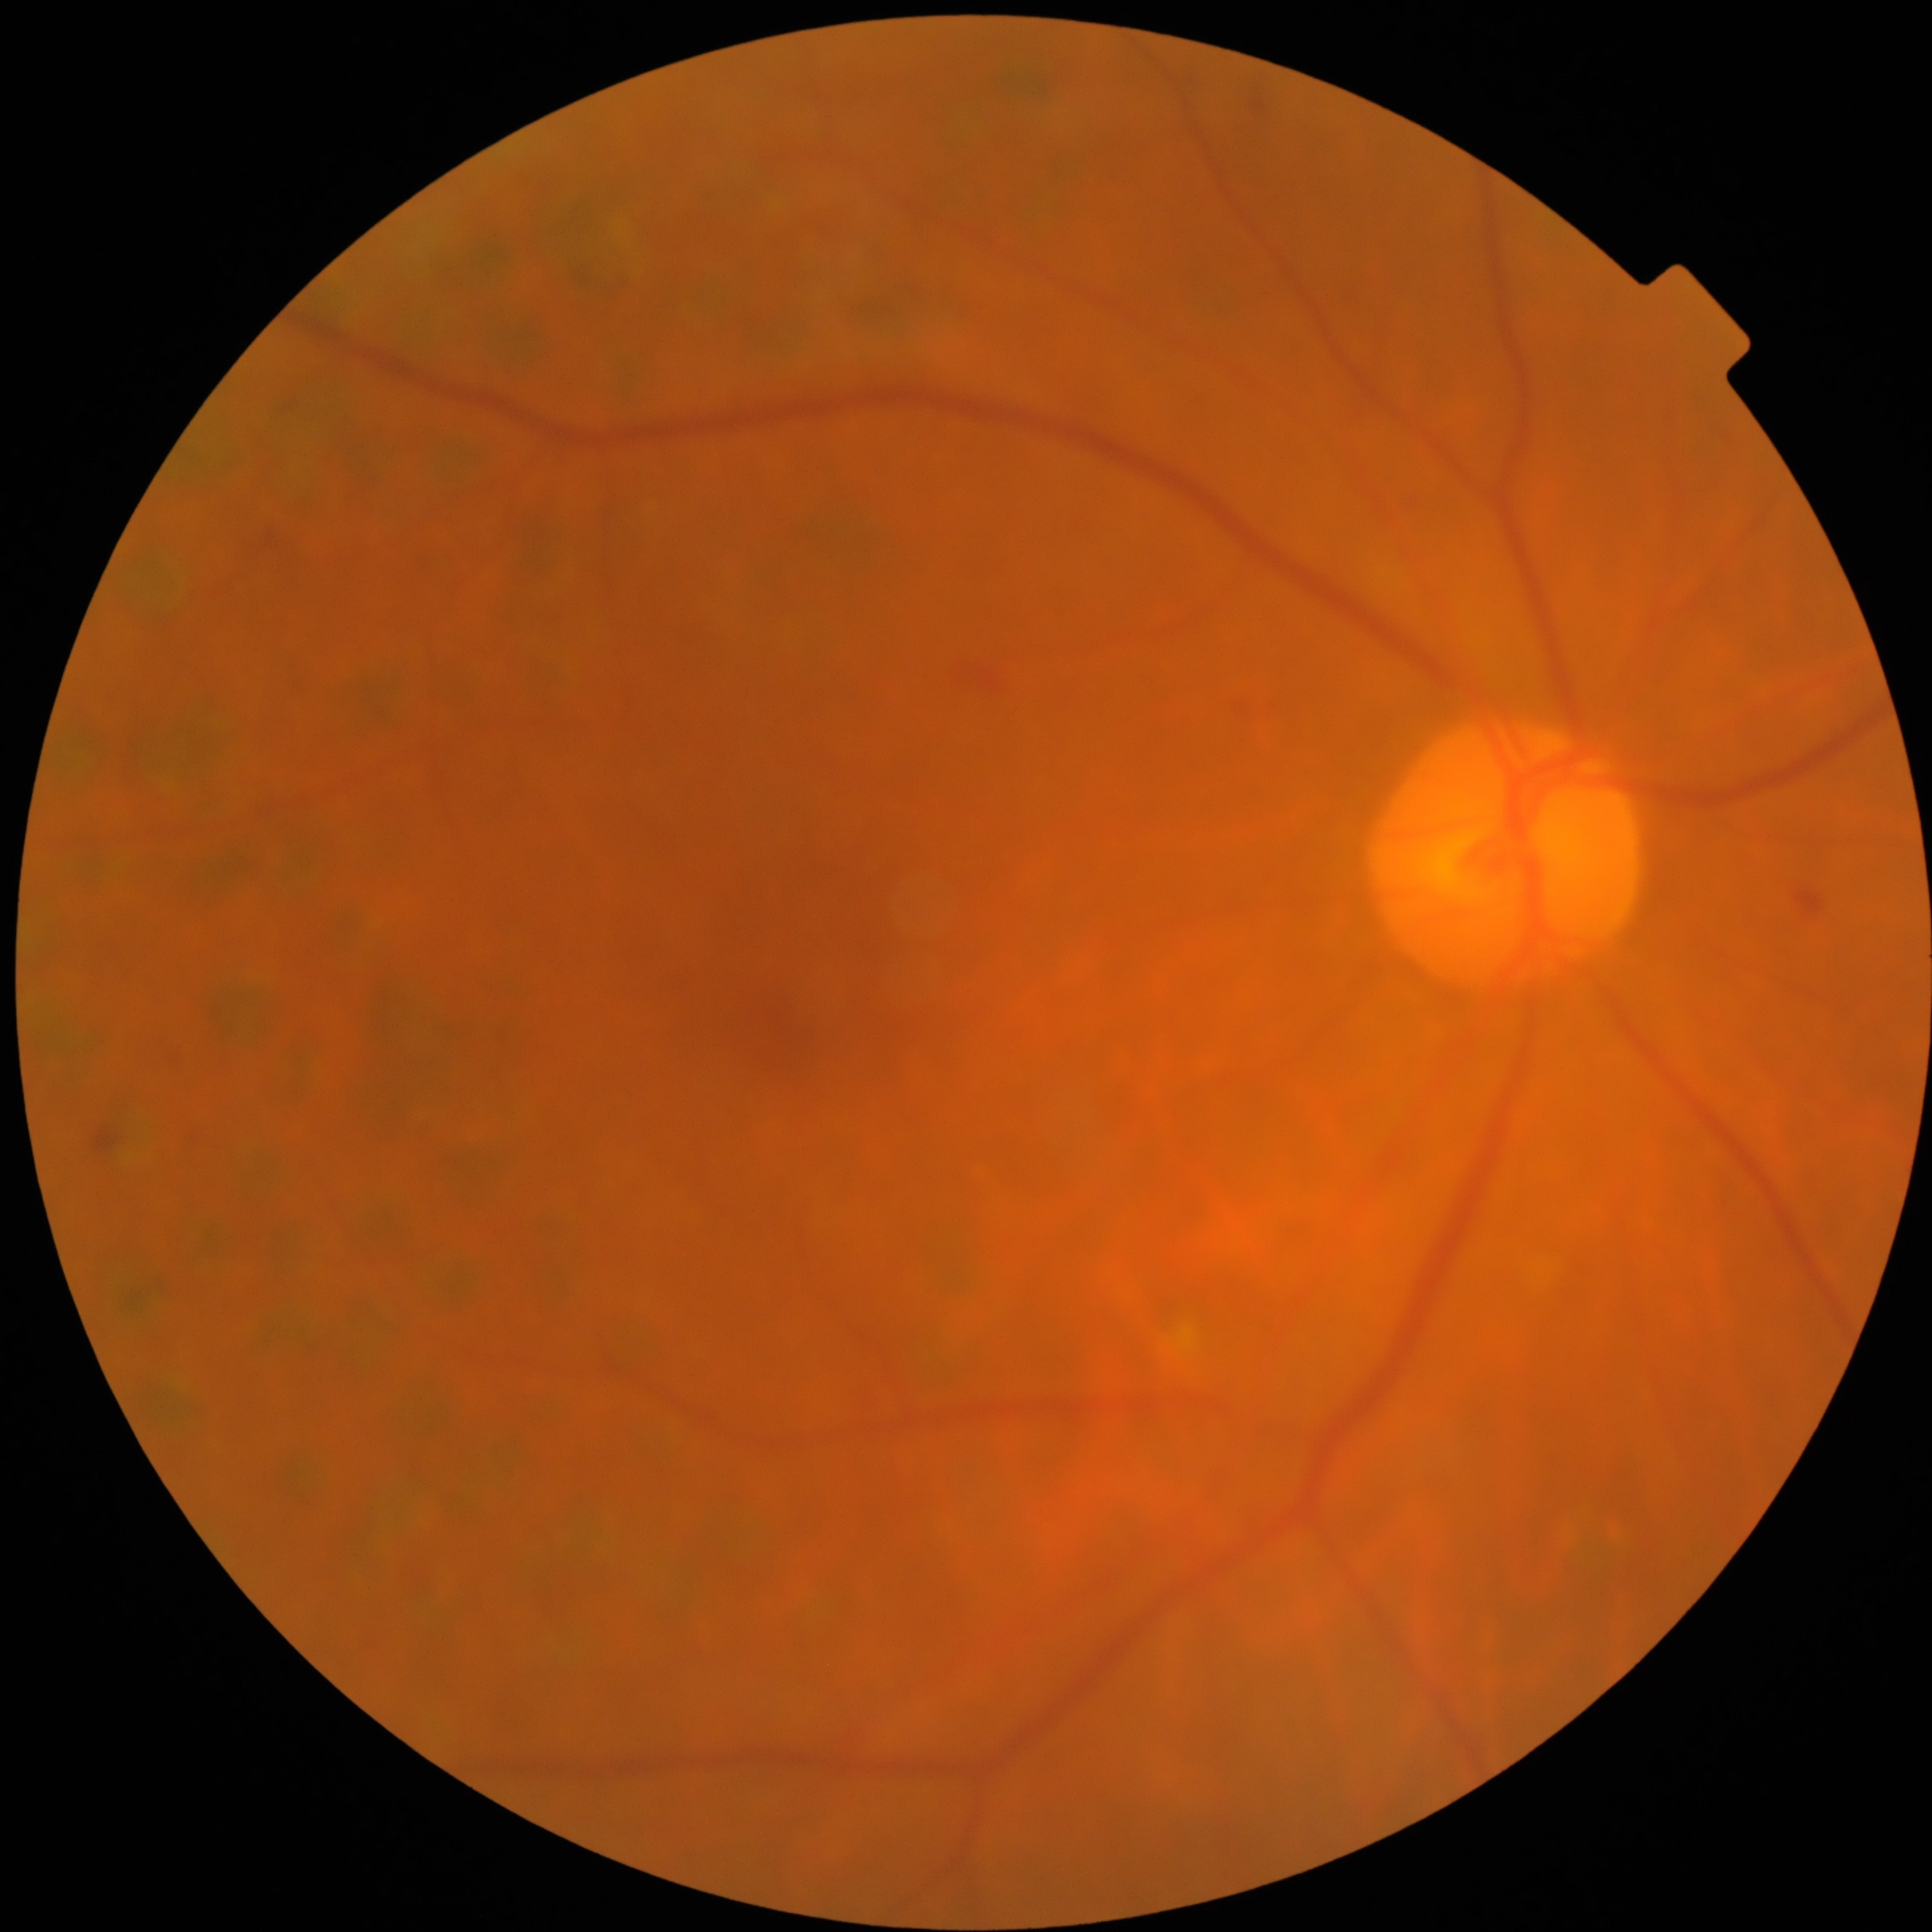 Diabetic retinopathy (DR) is 2 — more than just microaneurysms but less than severe NPDR.